45° FOV · color fundus image: 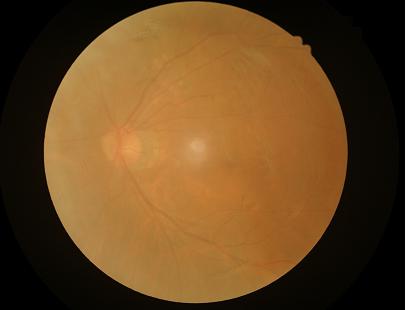

Quality assessment: contrast: low; illumination/color: satisfactory; clarity: blurry; overall: suboptimal.